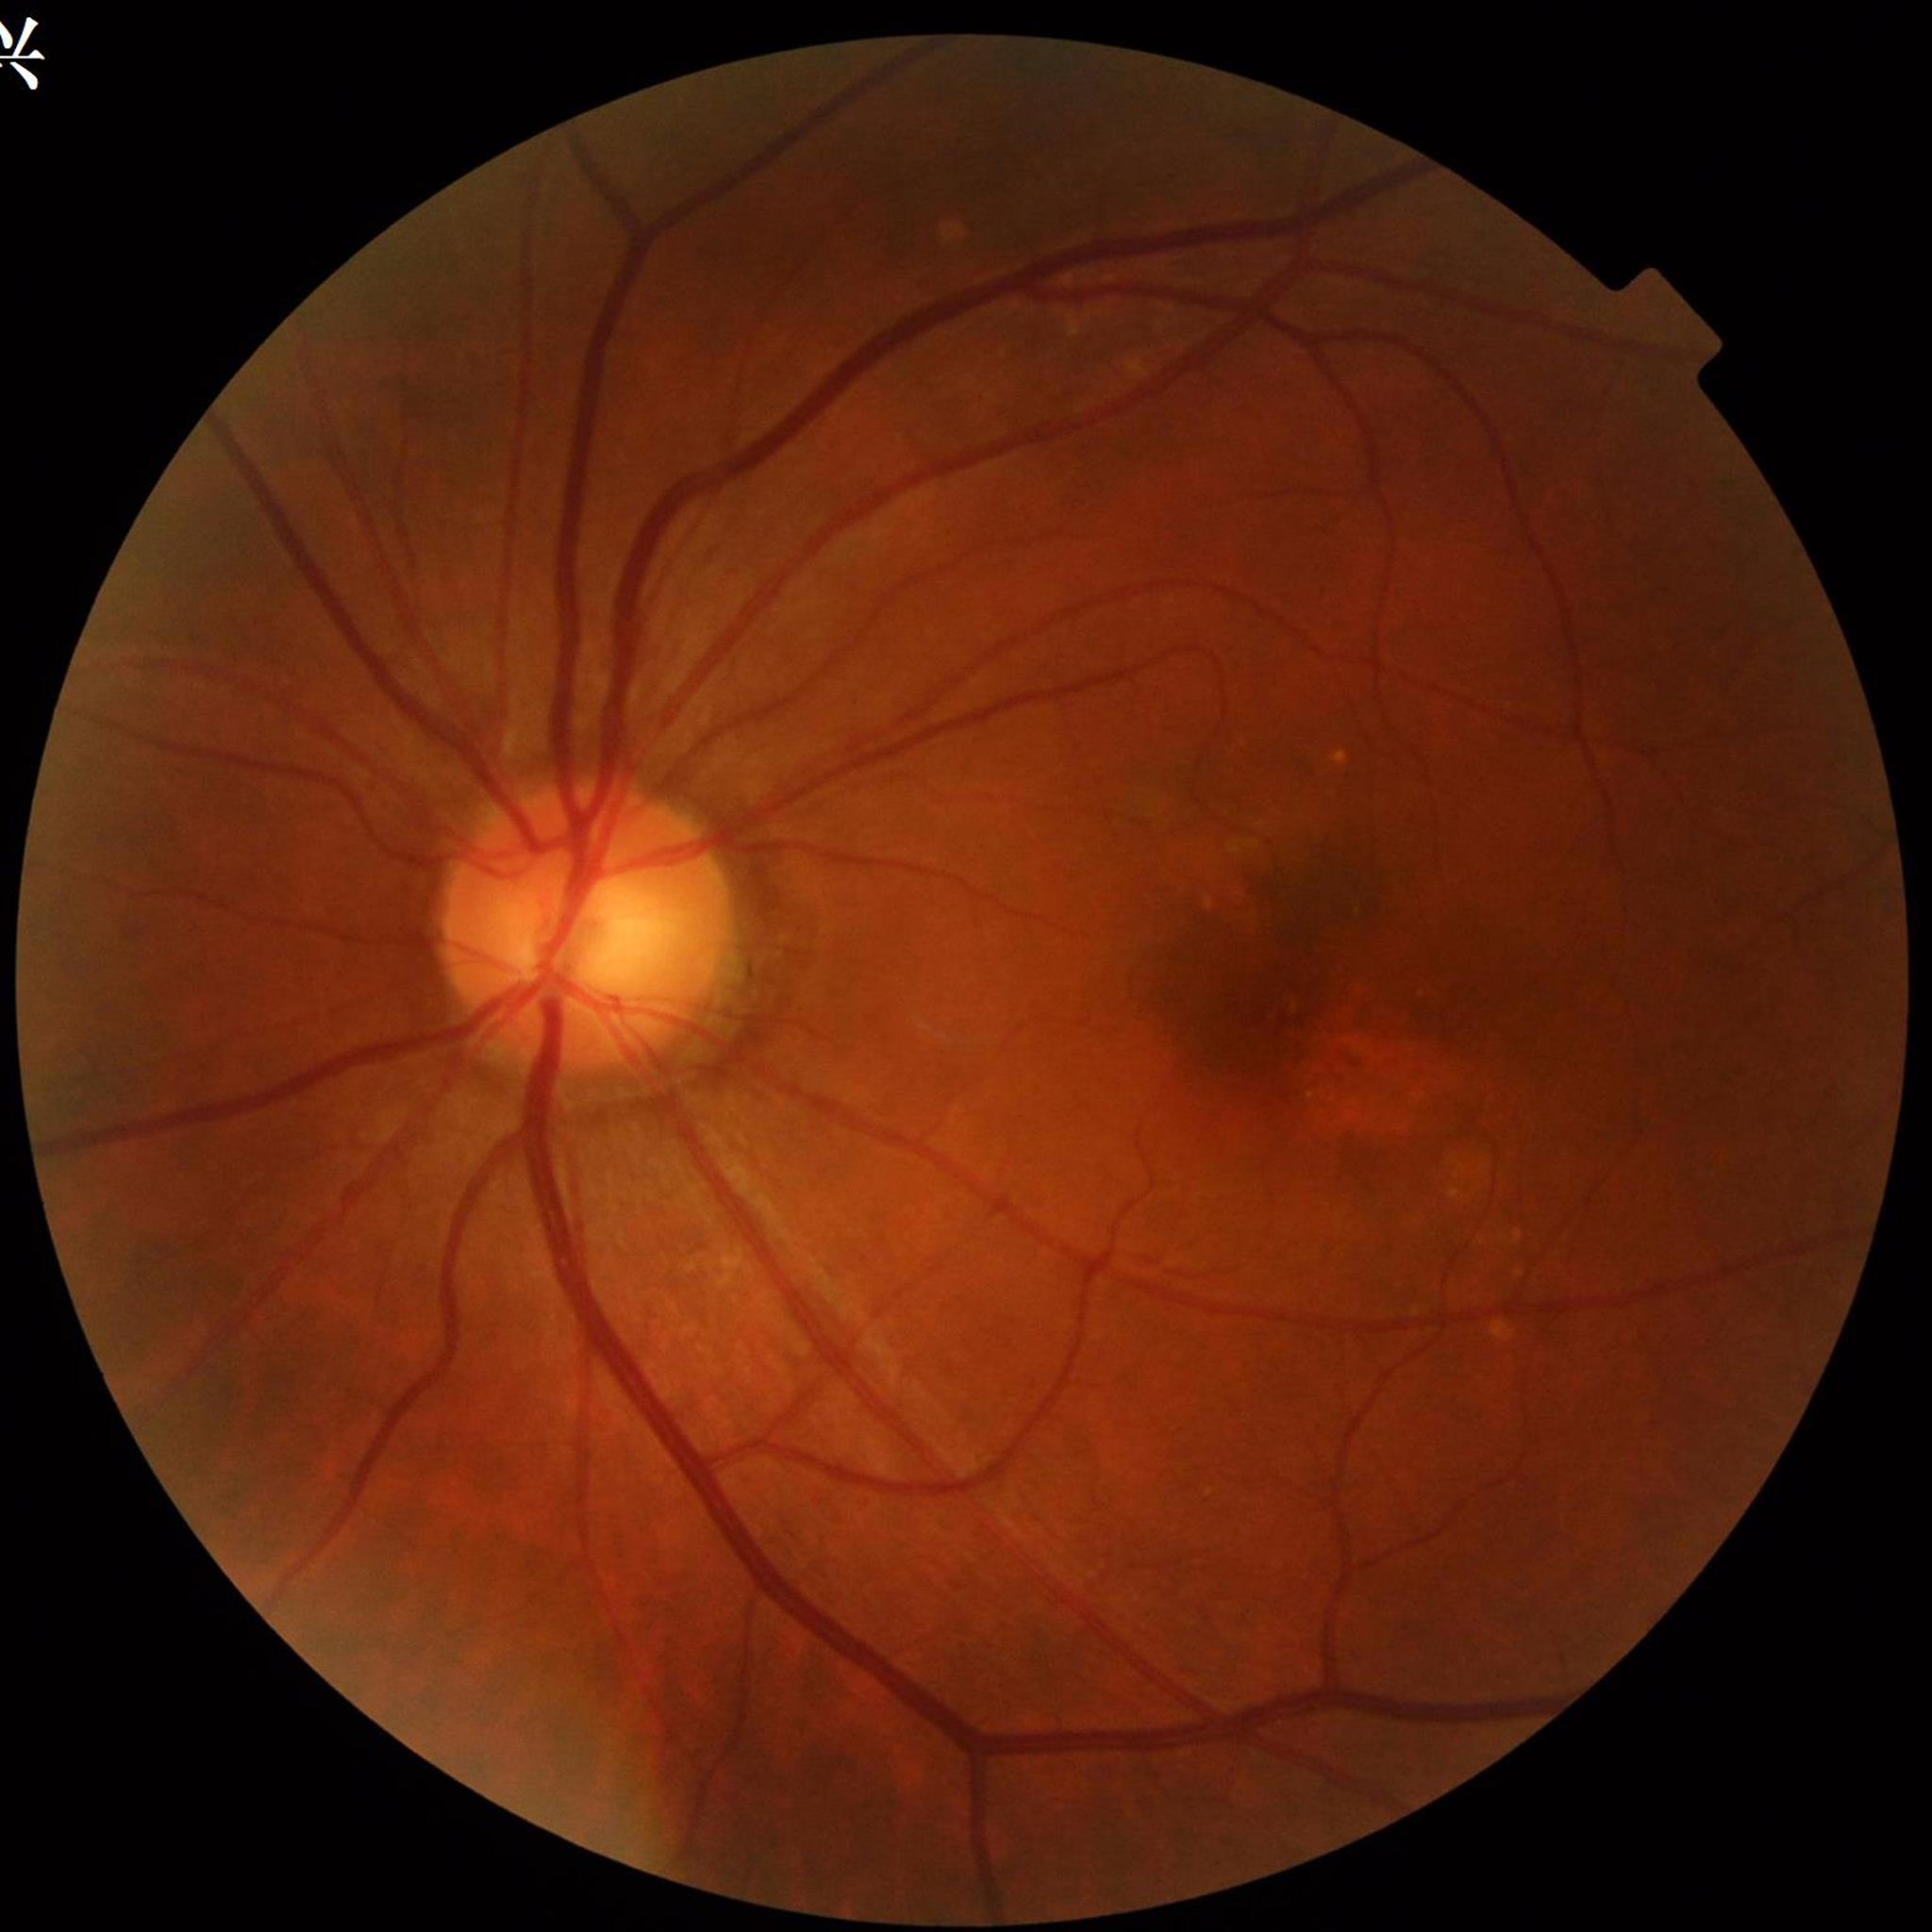
Clinical diagnosis: age-related macular degeneration